45° field of view, retinal fundus photograph: 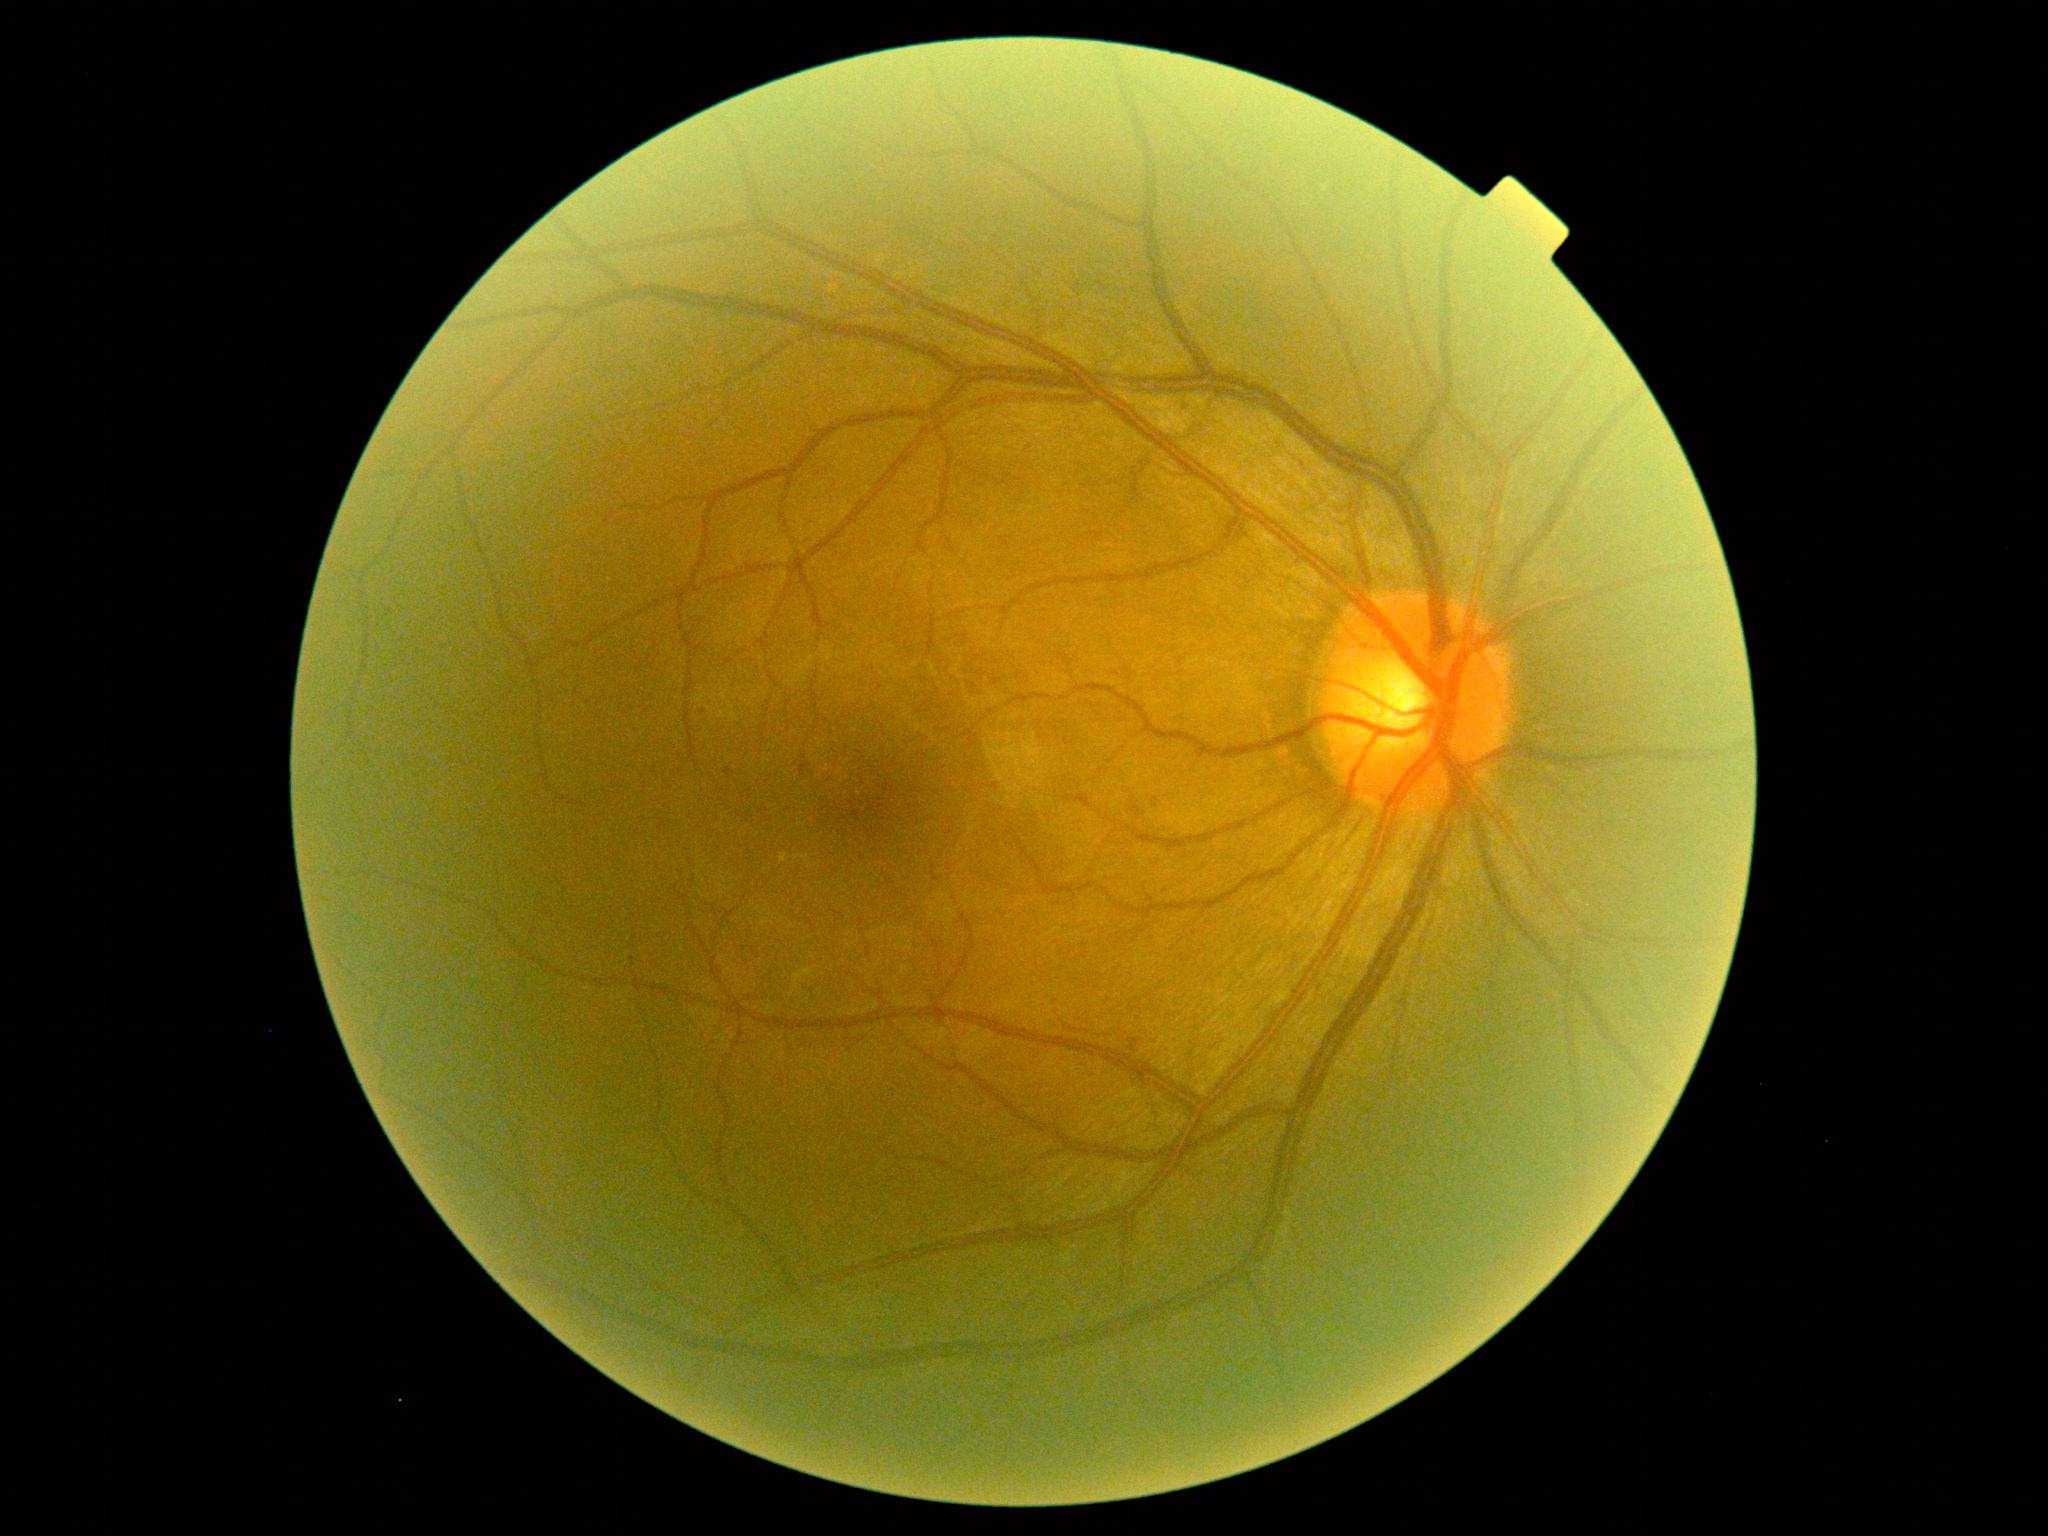 – DR class — non-proliferative diabetic retinopathy
– DR grade — 1 (mild NPDR)